2048 by 1536 pixels, 45° FOV.
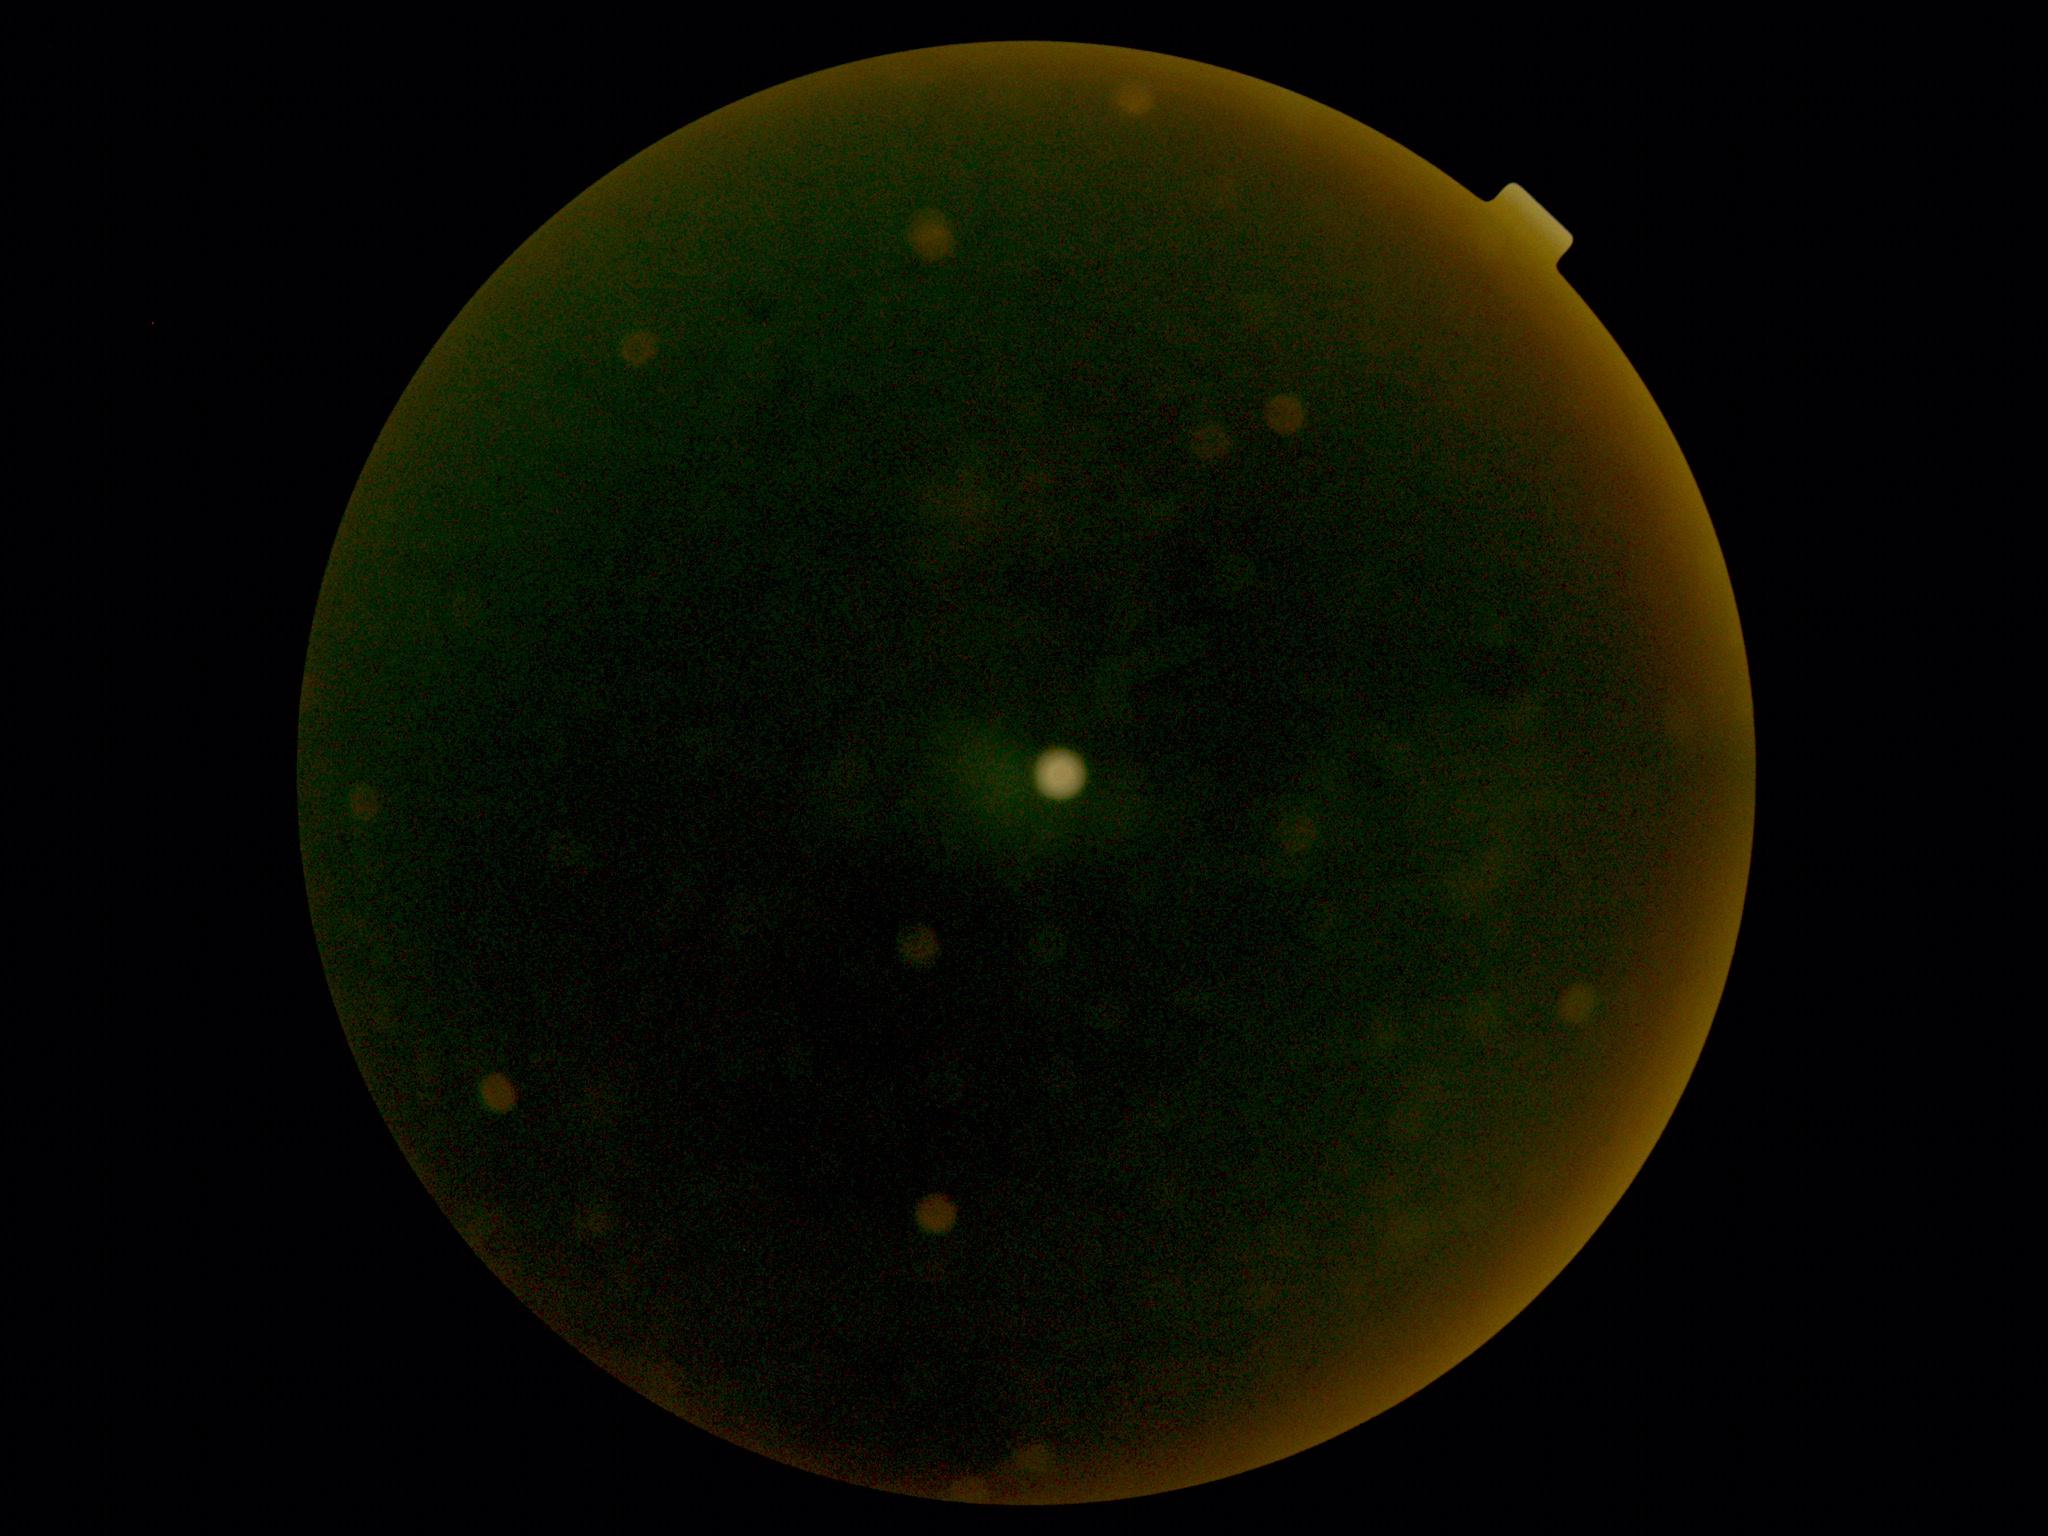 Image quality is insufficient for diabetic retinopathy assessment.
DR severity is ungradable.